45° field of view. 1936x1296px: 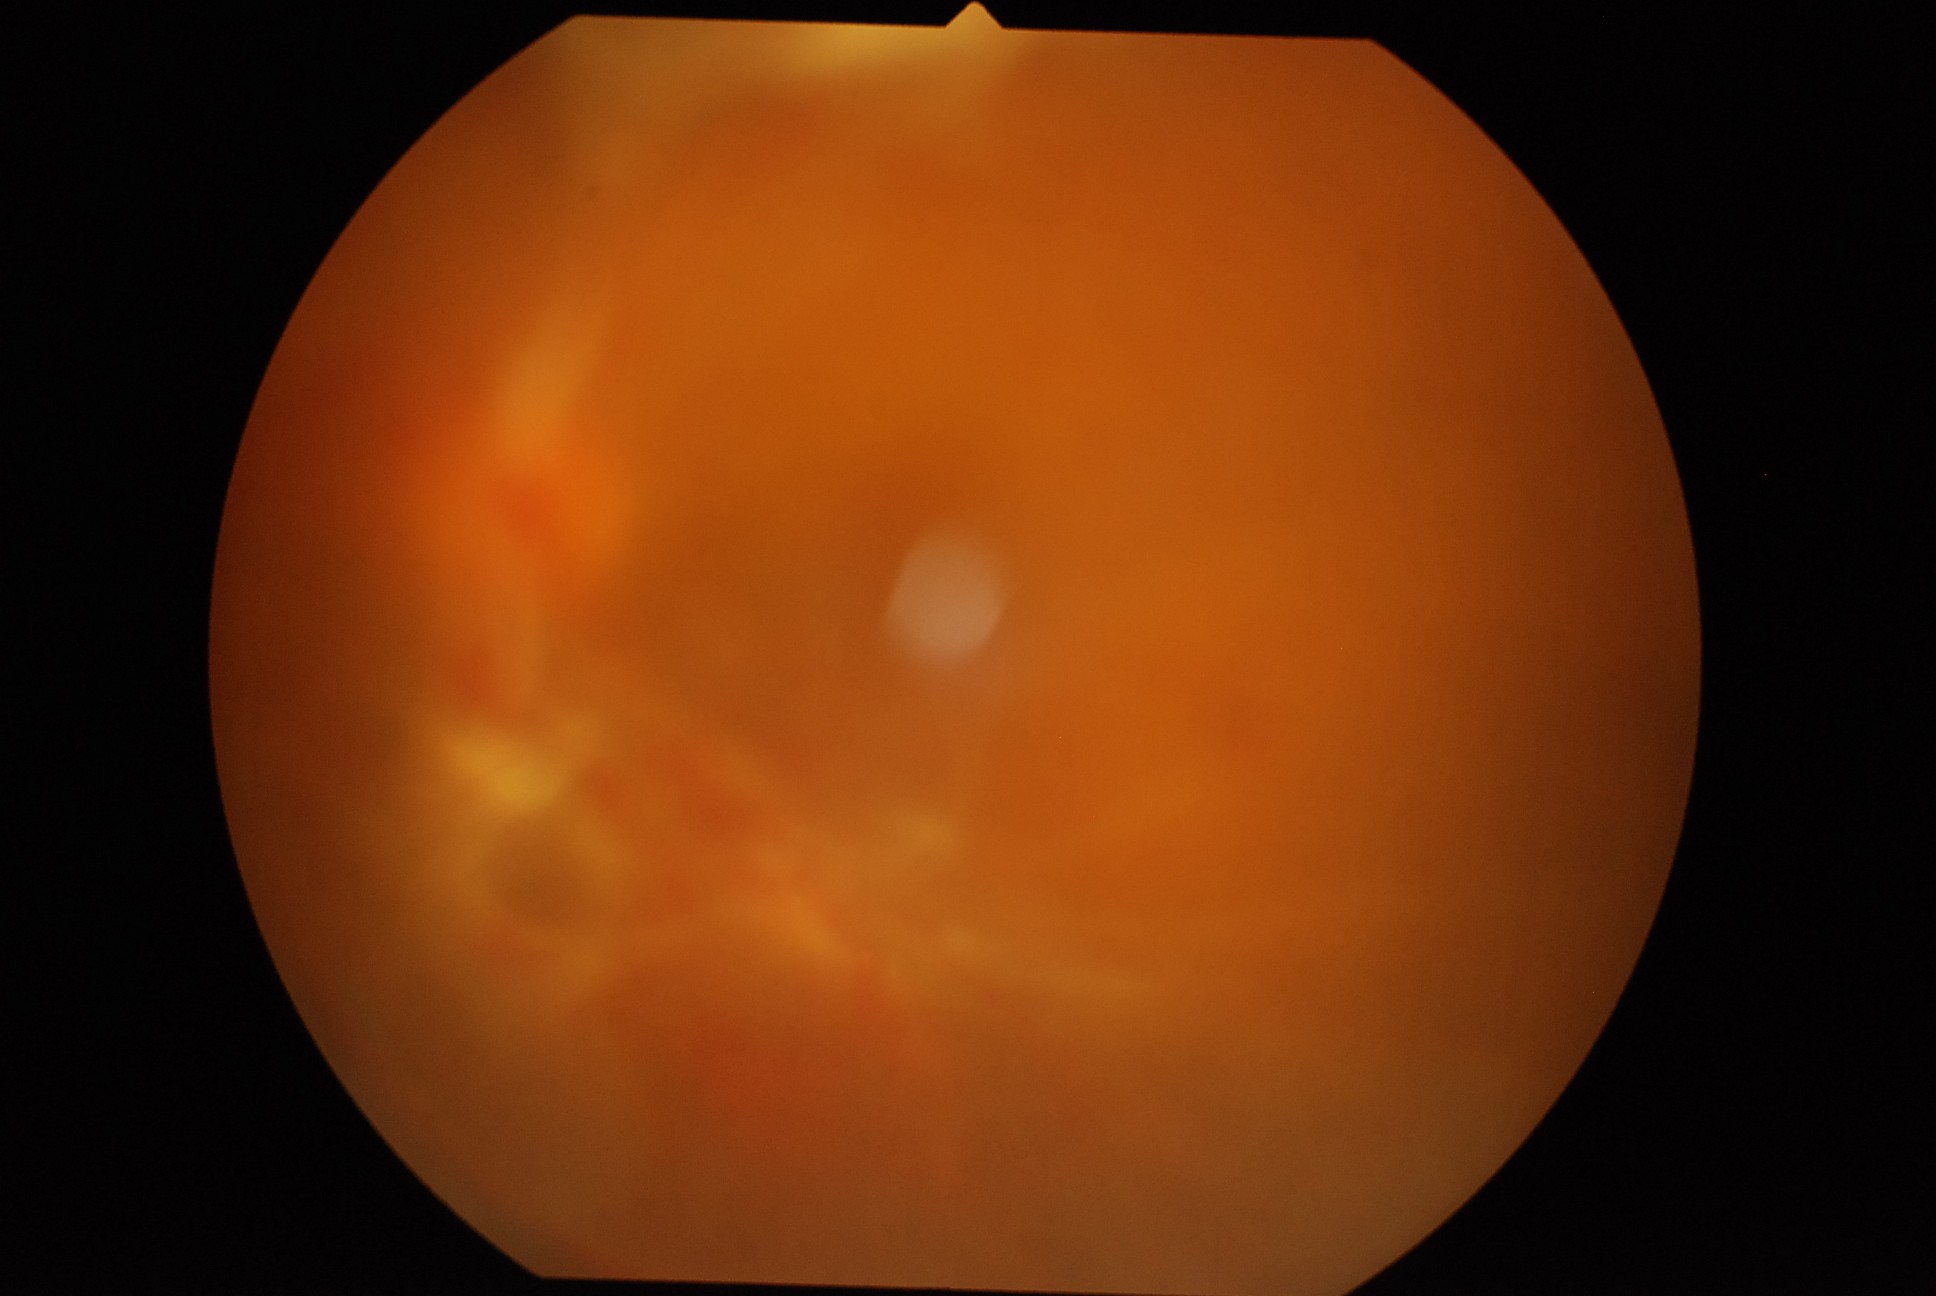

DR stage is PDR (grade 4).